Fundus photo: 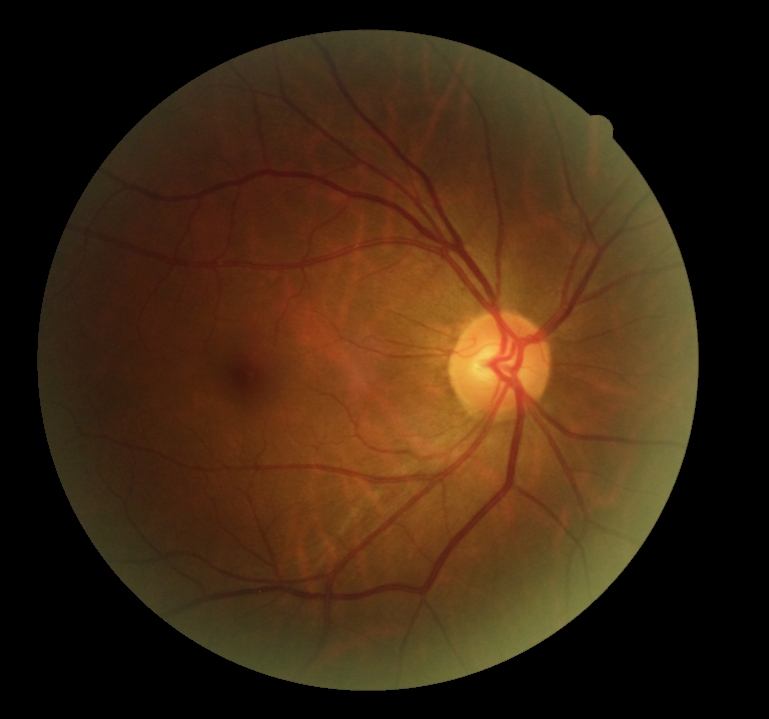 DR stage: no apparent diabetic retinopathy (grade 0).